640x480px; pediatric wide-field fundus photograph: 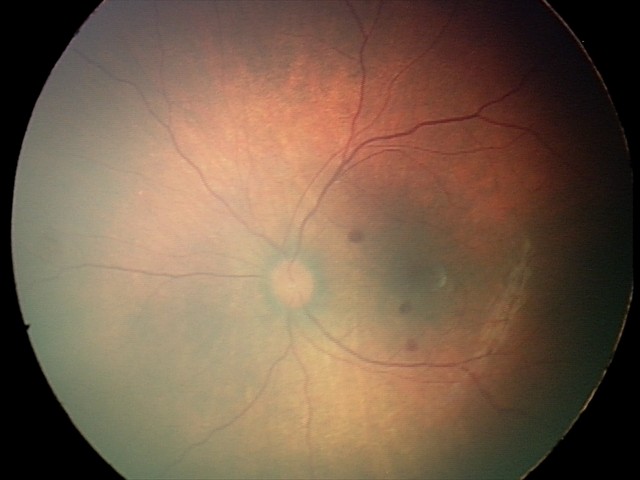 Screening examination consistent with retinal hemorrhages.